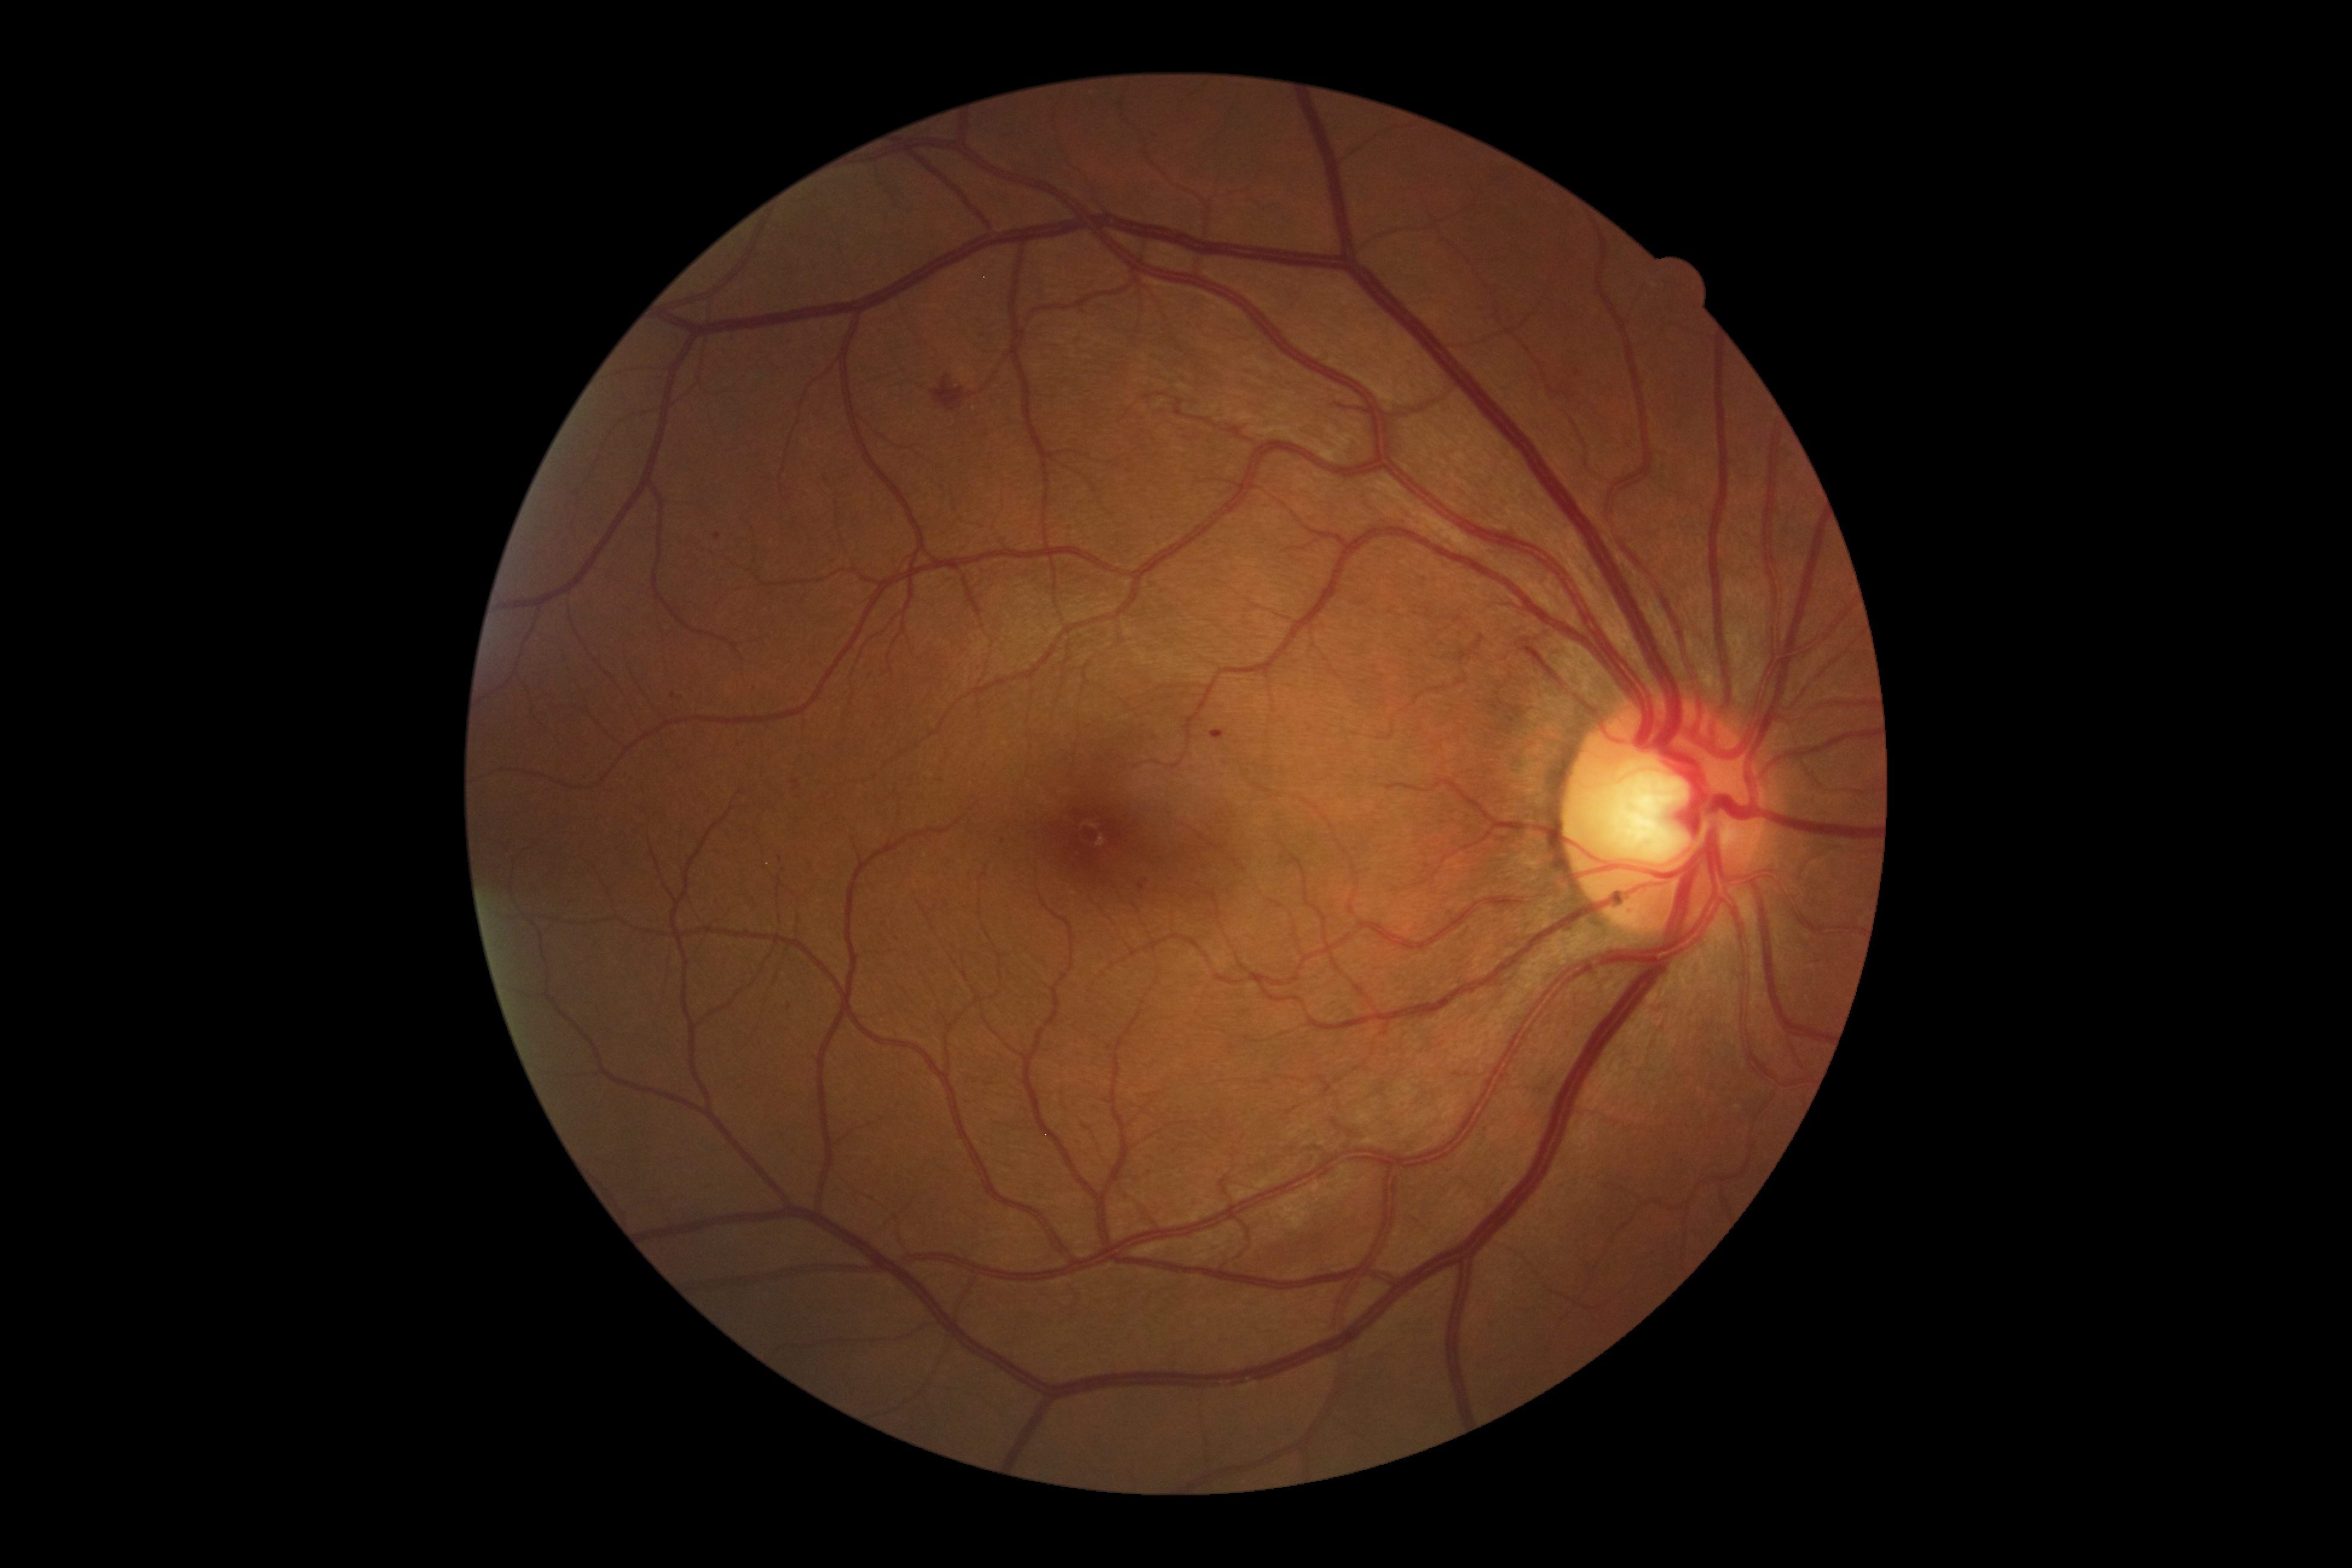 Diabetic retinopathy severity is 2.